512 x 512 pixels — 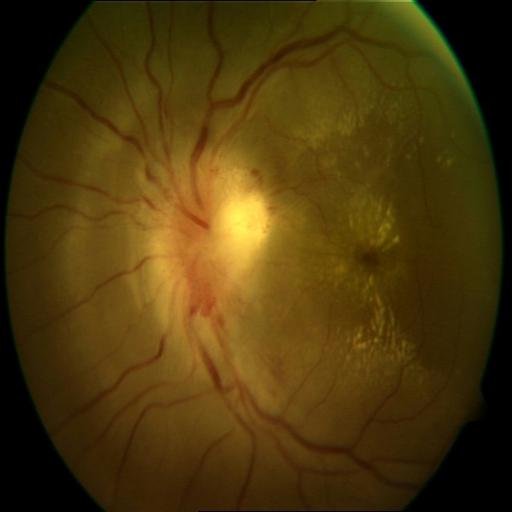

Diagnosis (3): anterior ischemic optic neuropathy | optic disc edema | exudation.